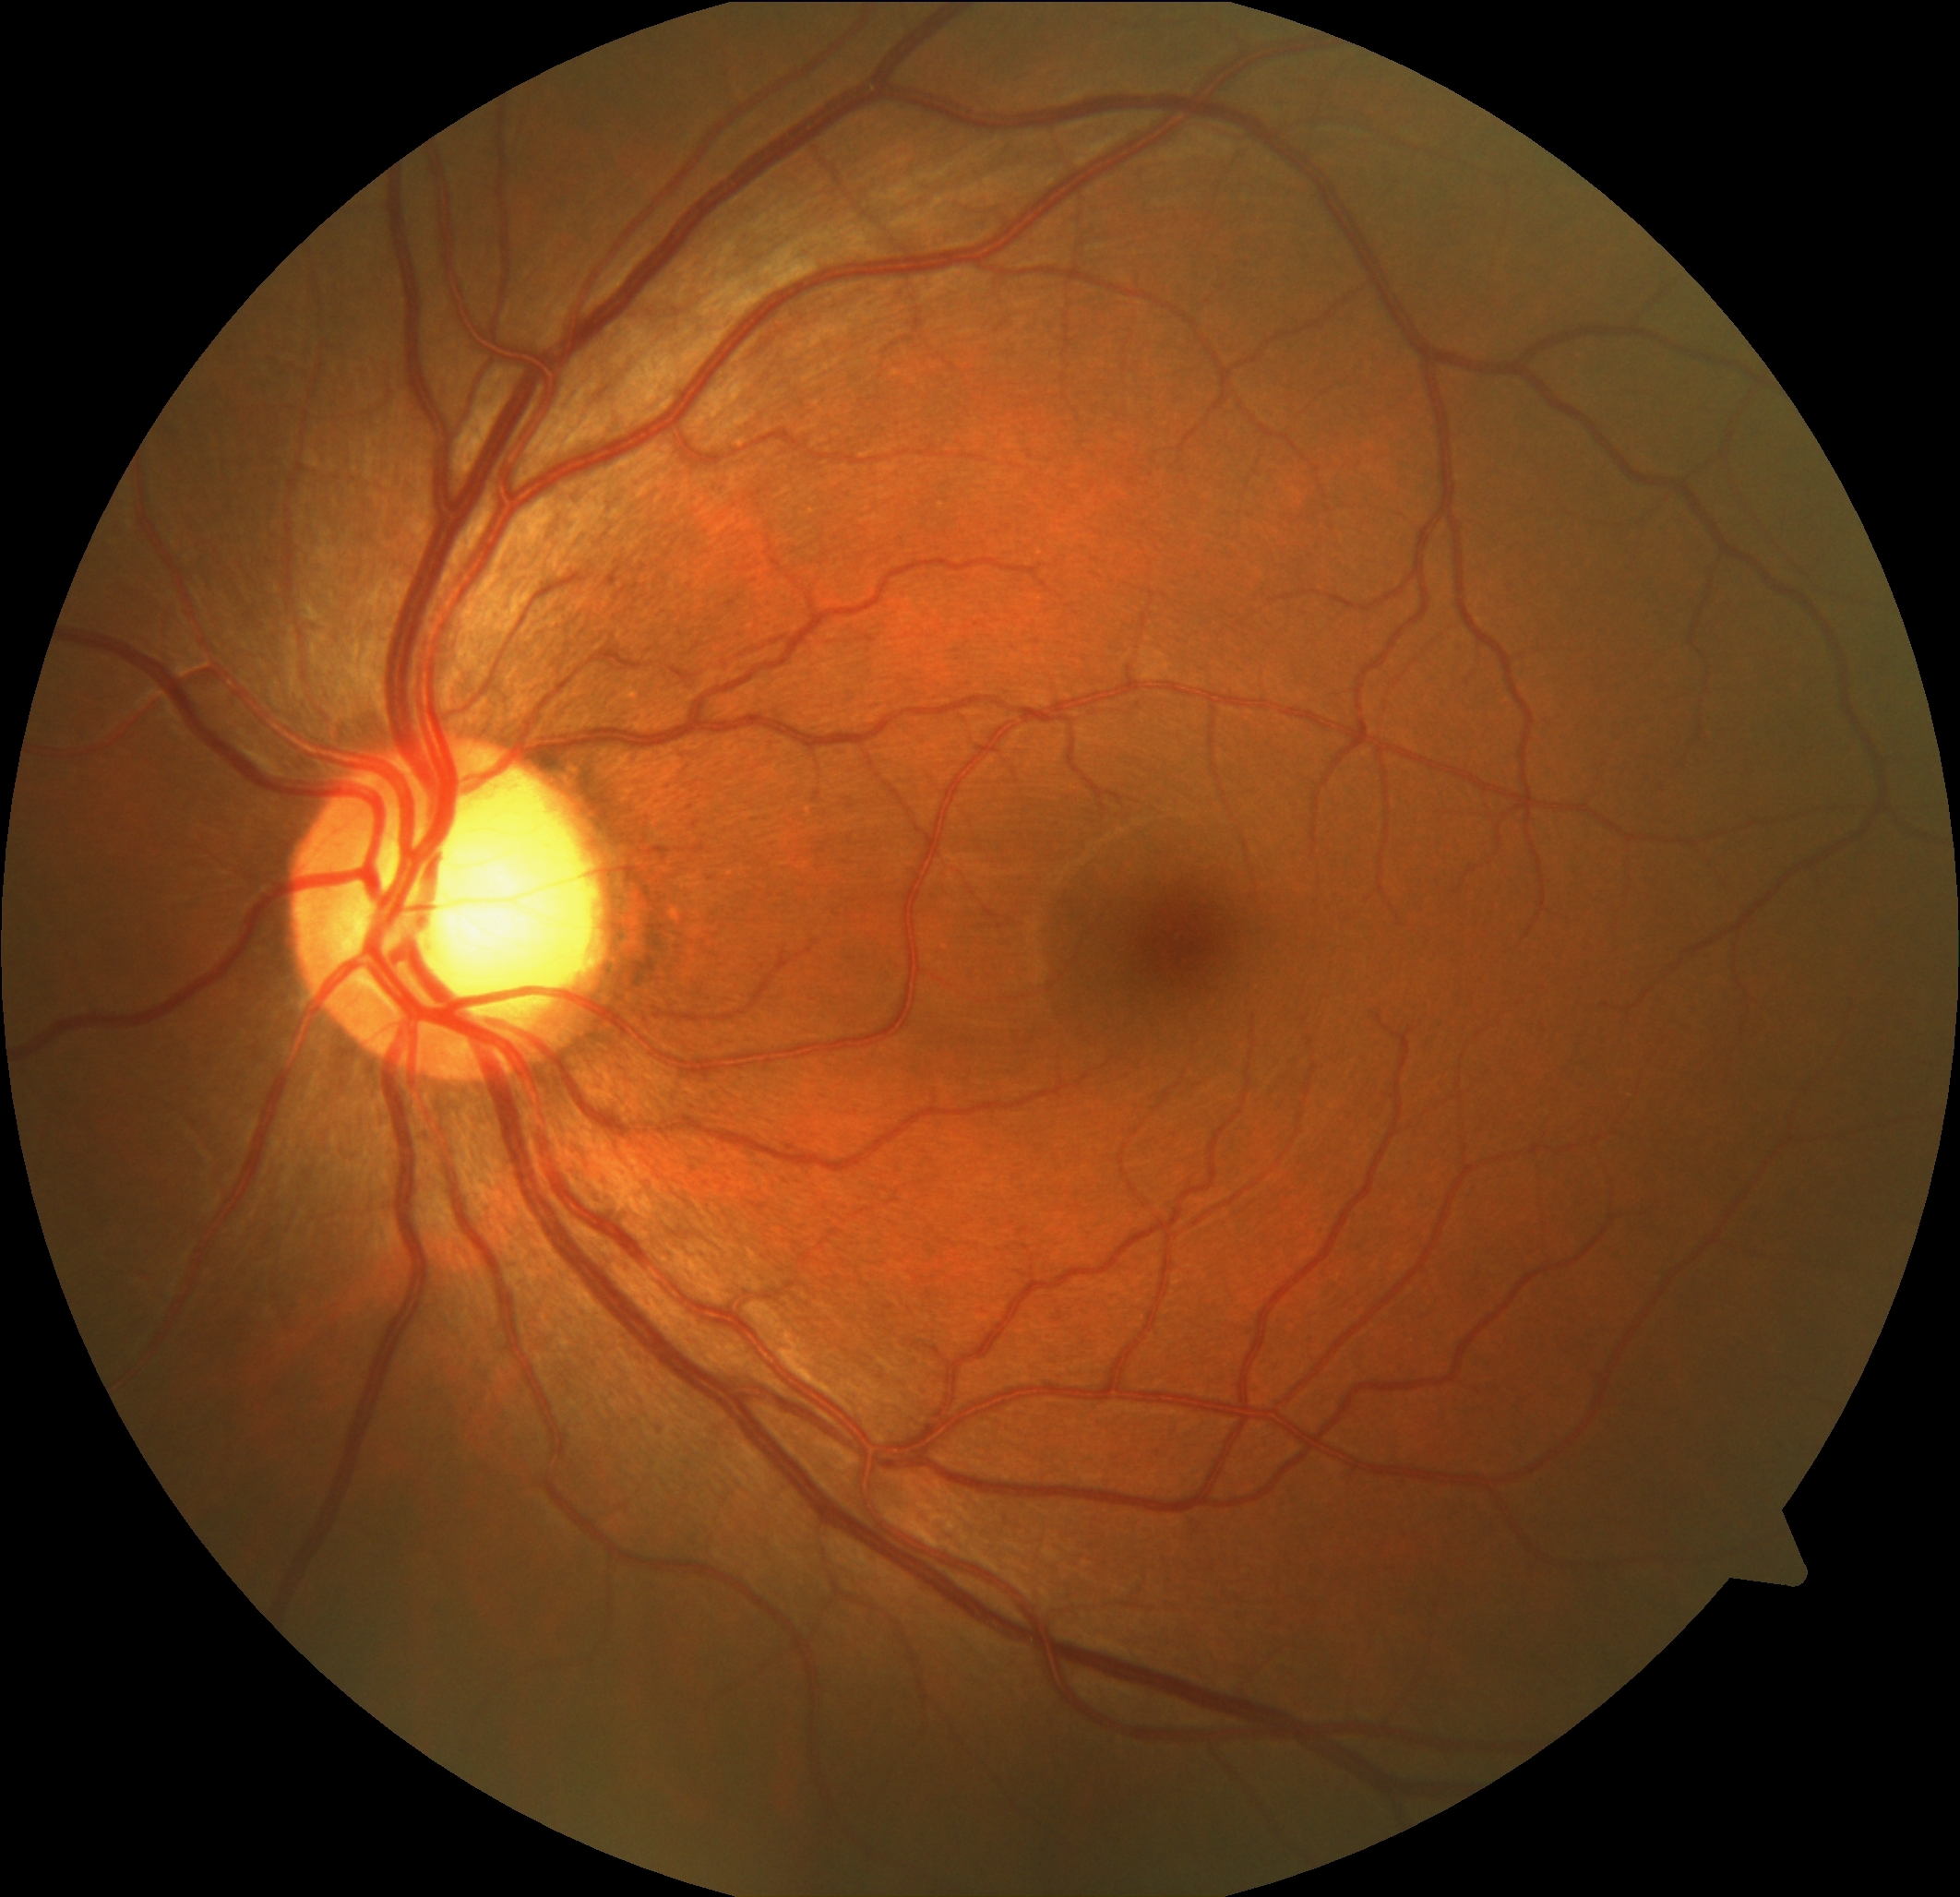
DR grade is mild non-proliferative diabetic retinopathy (1).